Clarity RetCam 3, 130° FOV · wide-field fundus photograph of an infant.
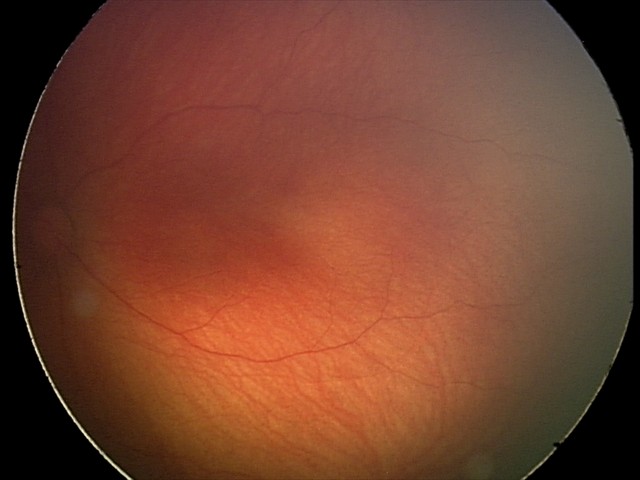 Screening series with retinal hemorrhages.